45° FOV — 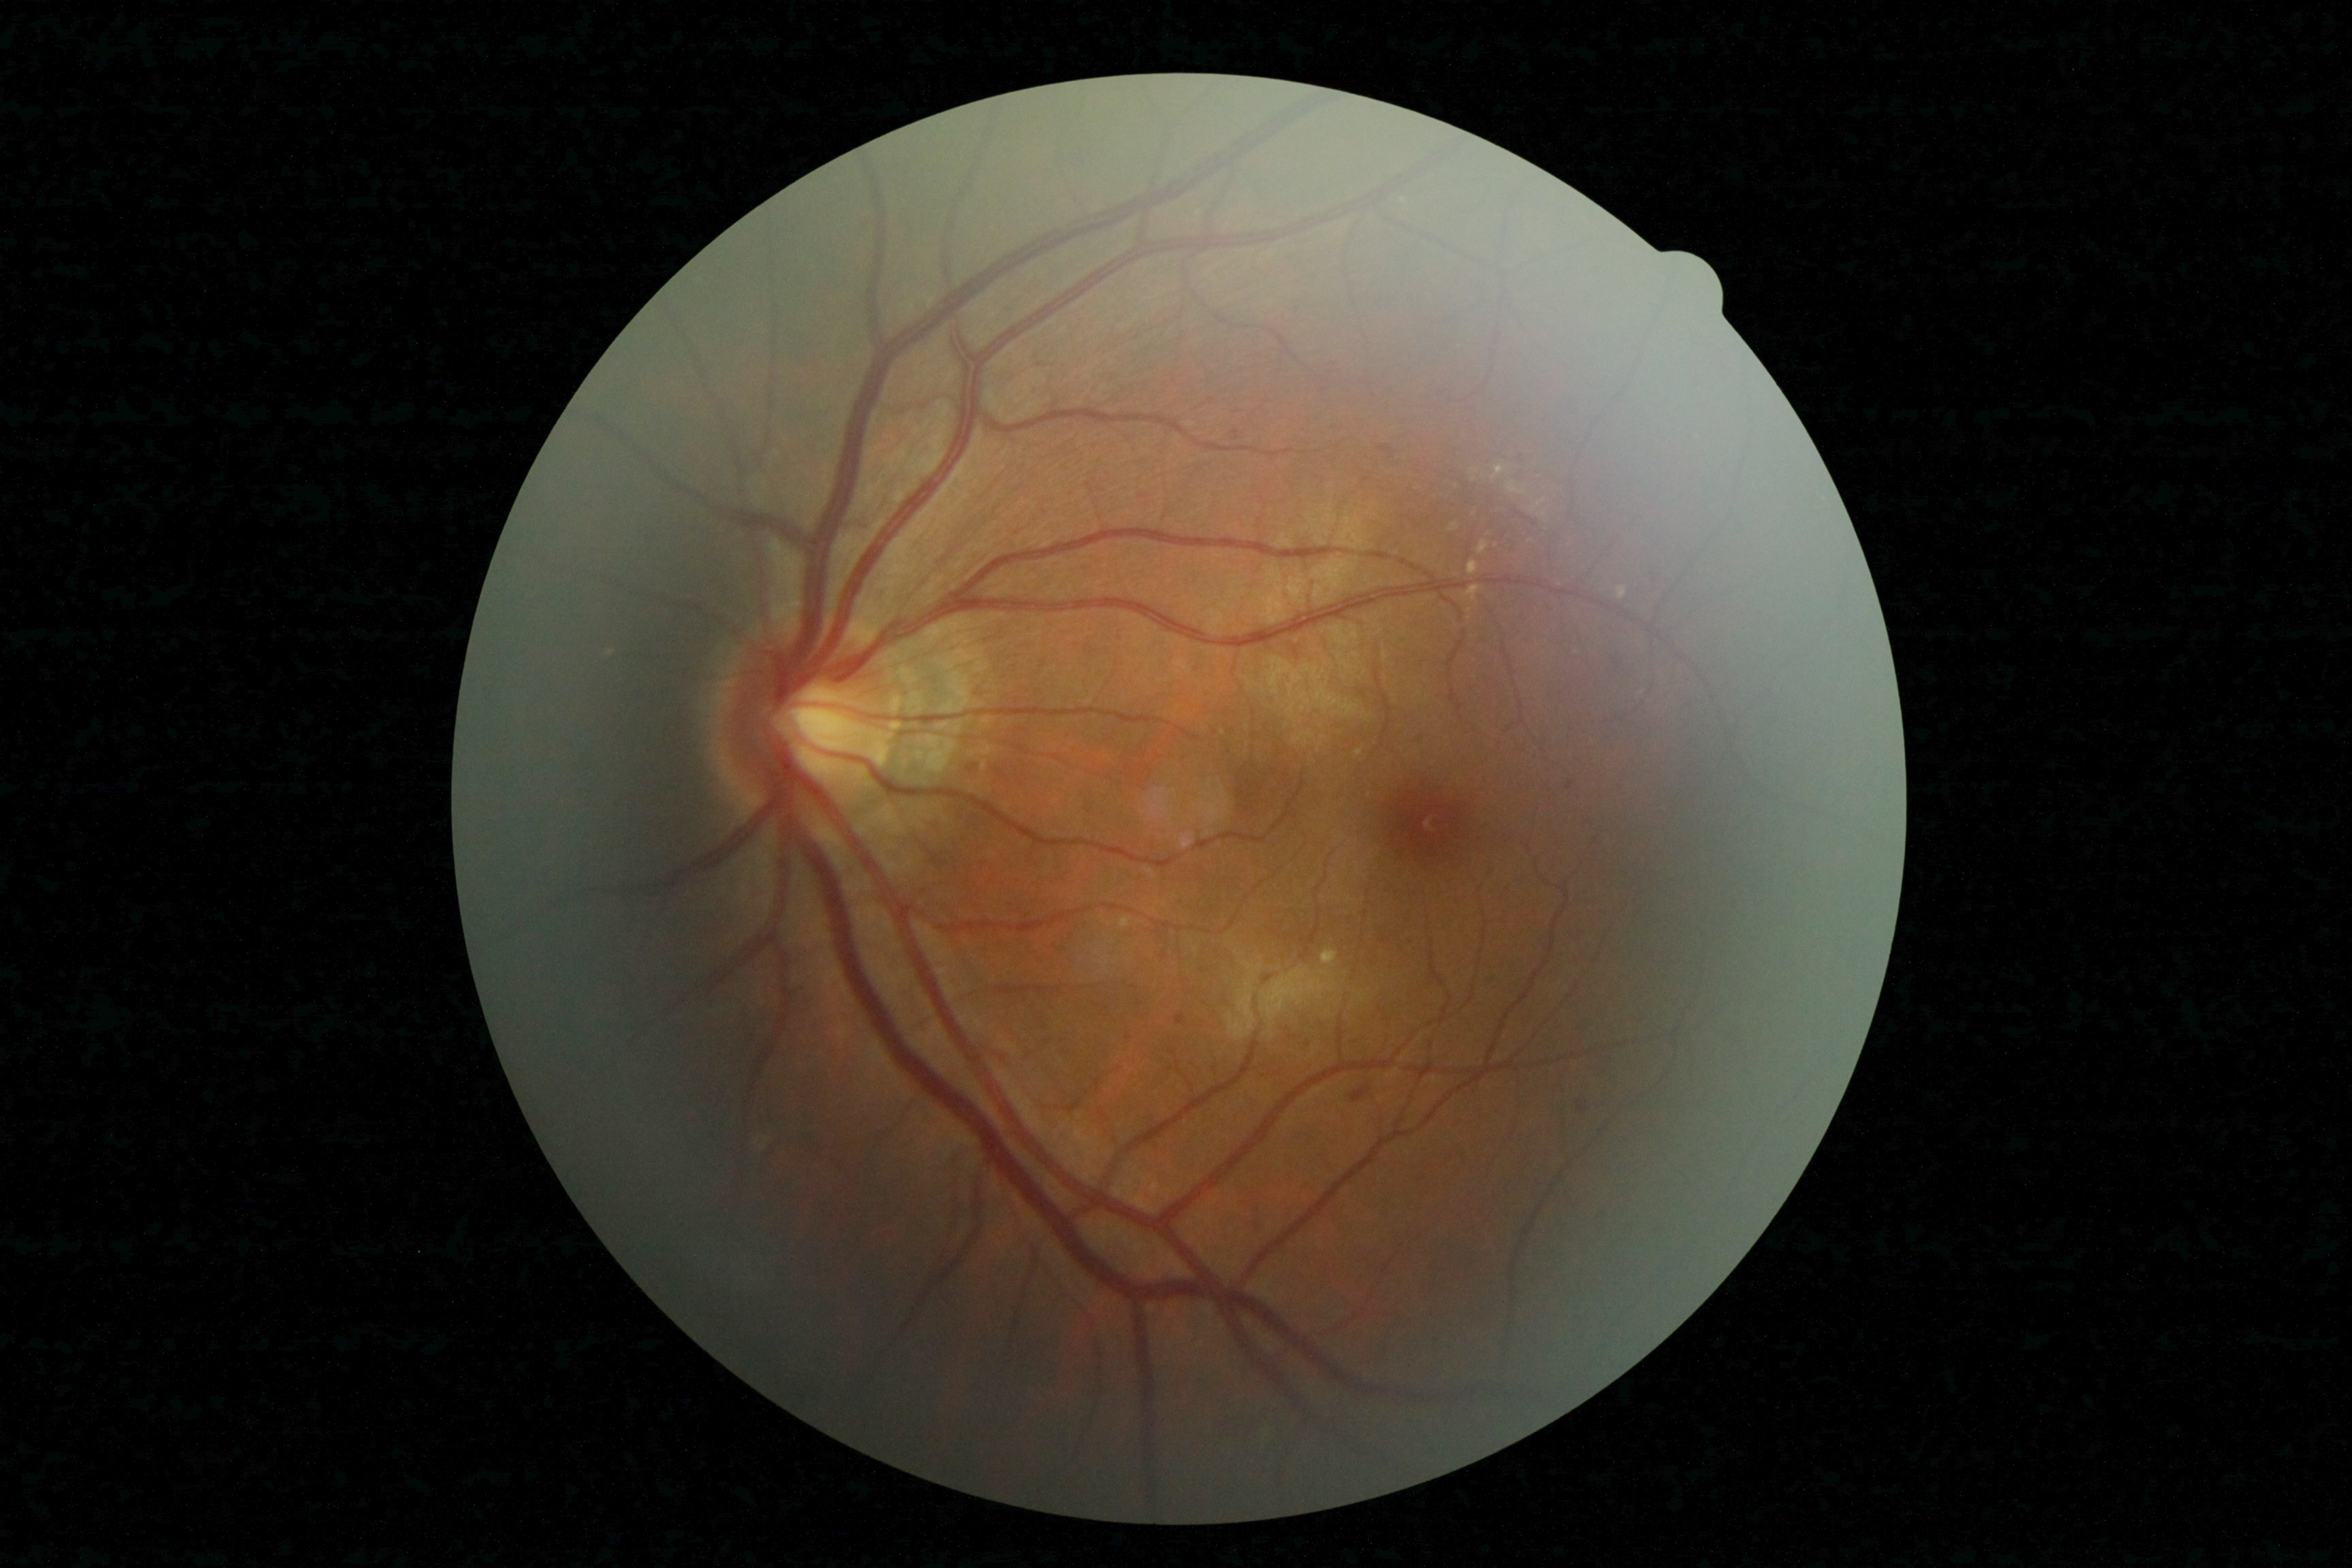

  dr_grade: 2/4